1932 x 1932 pixels: 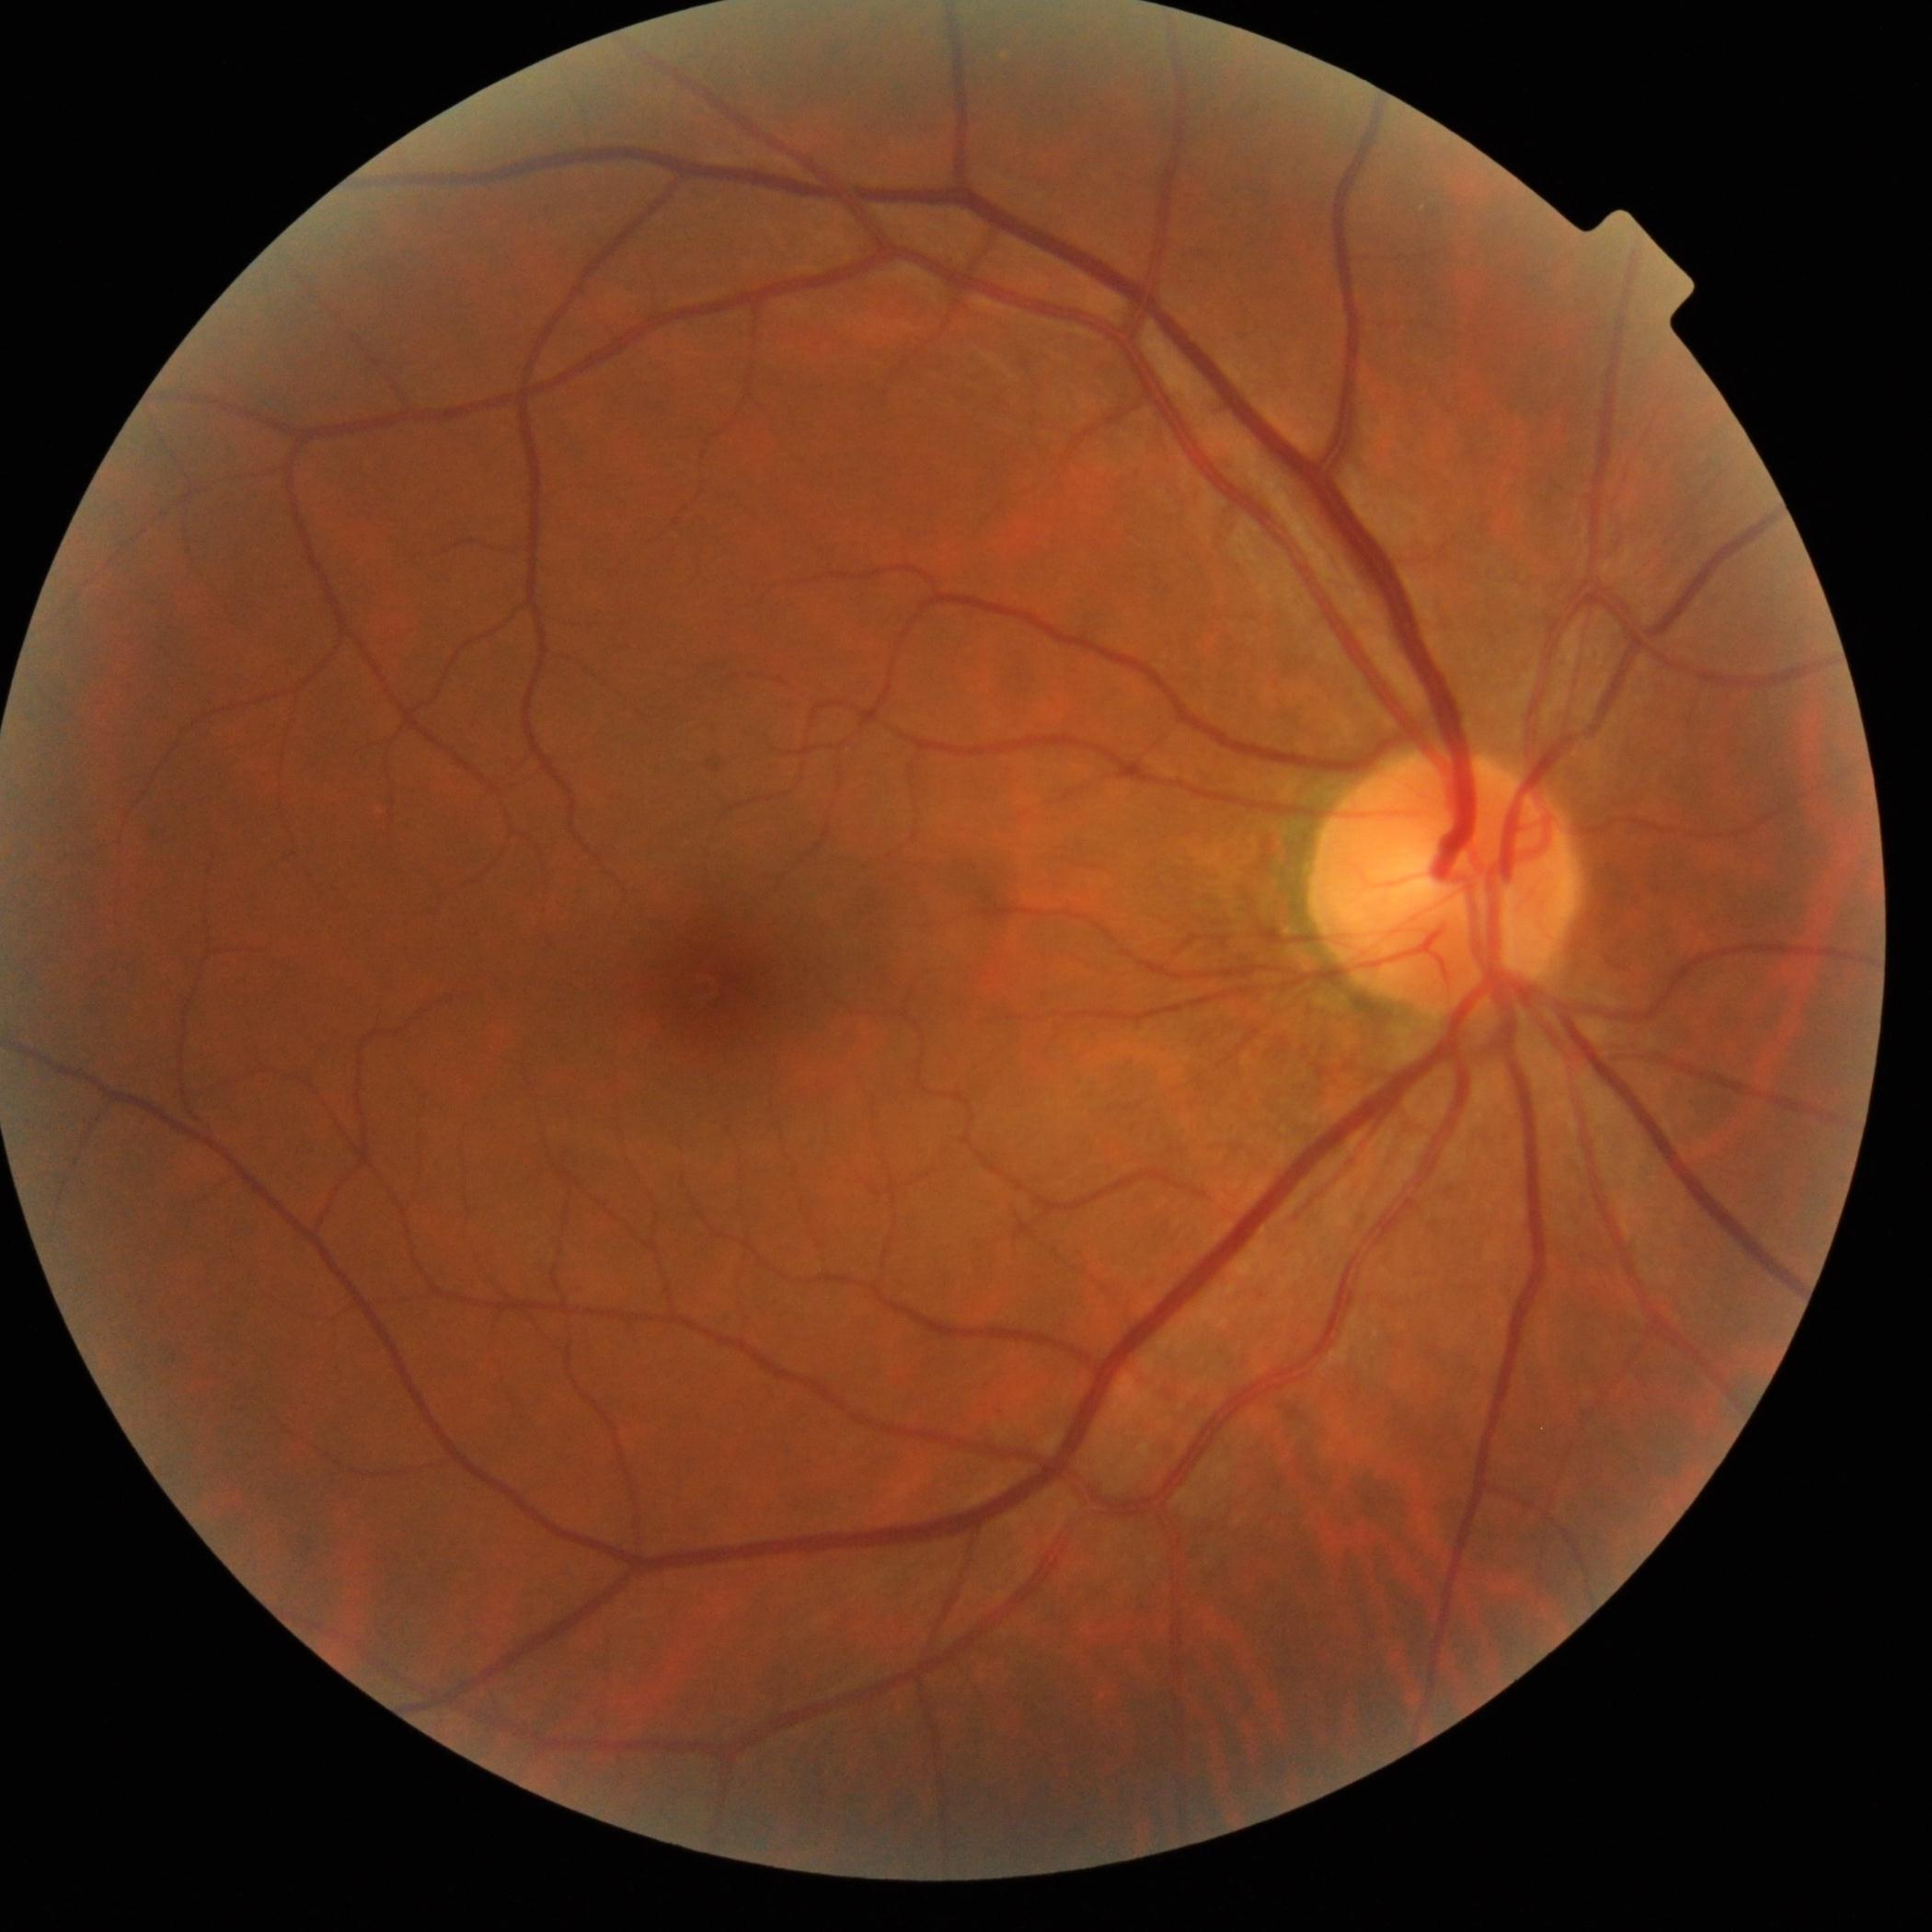
DR stage: grade 0 (no apparent retinopathy)
DR impression: no apparent DR